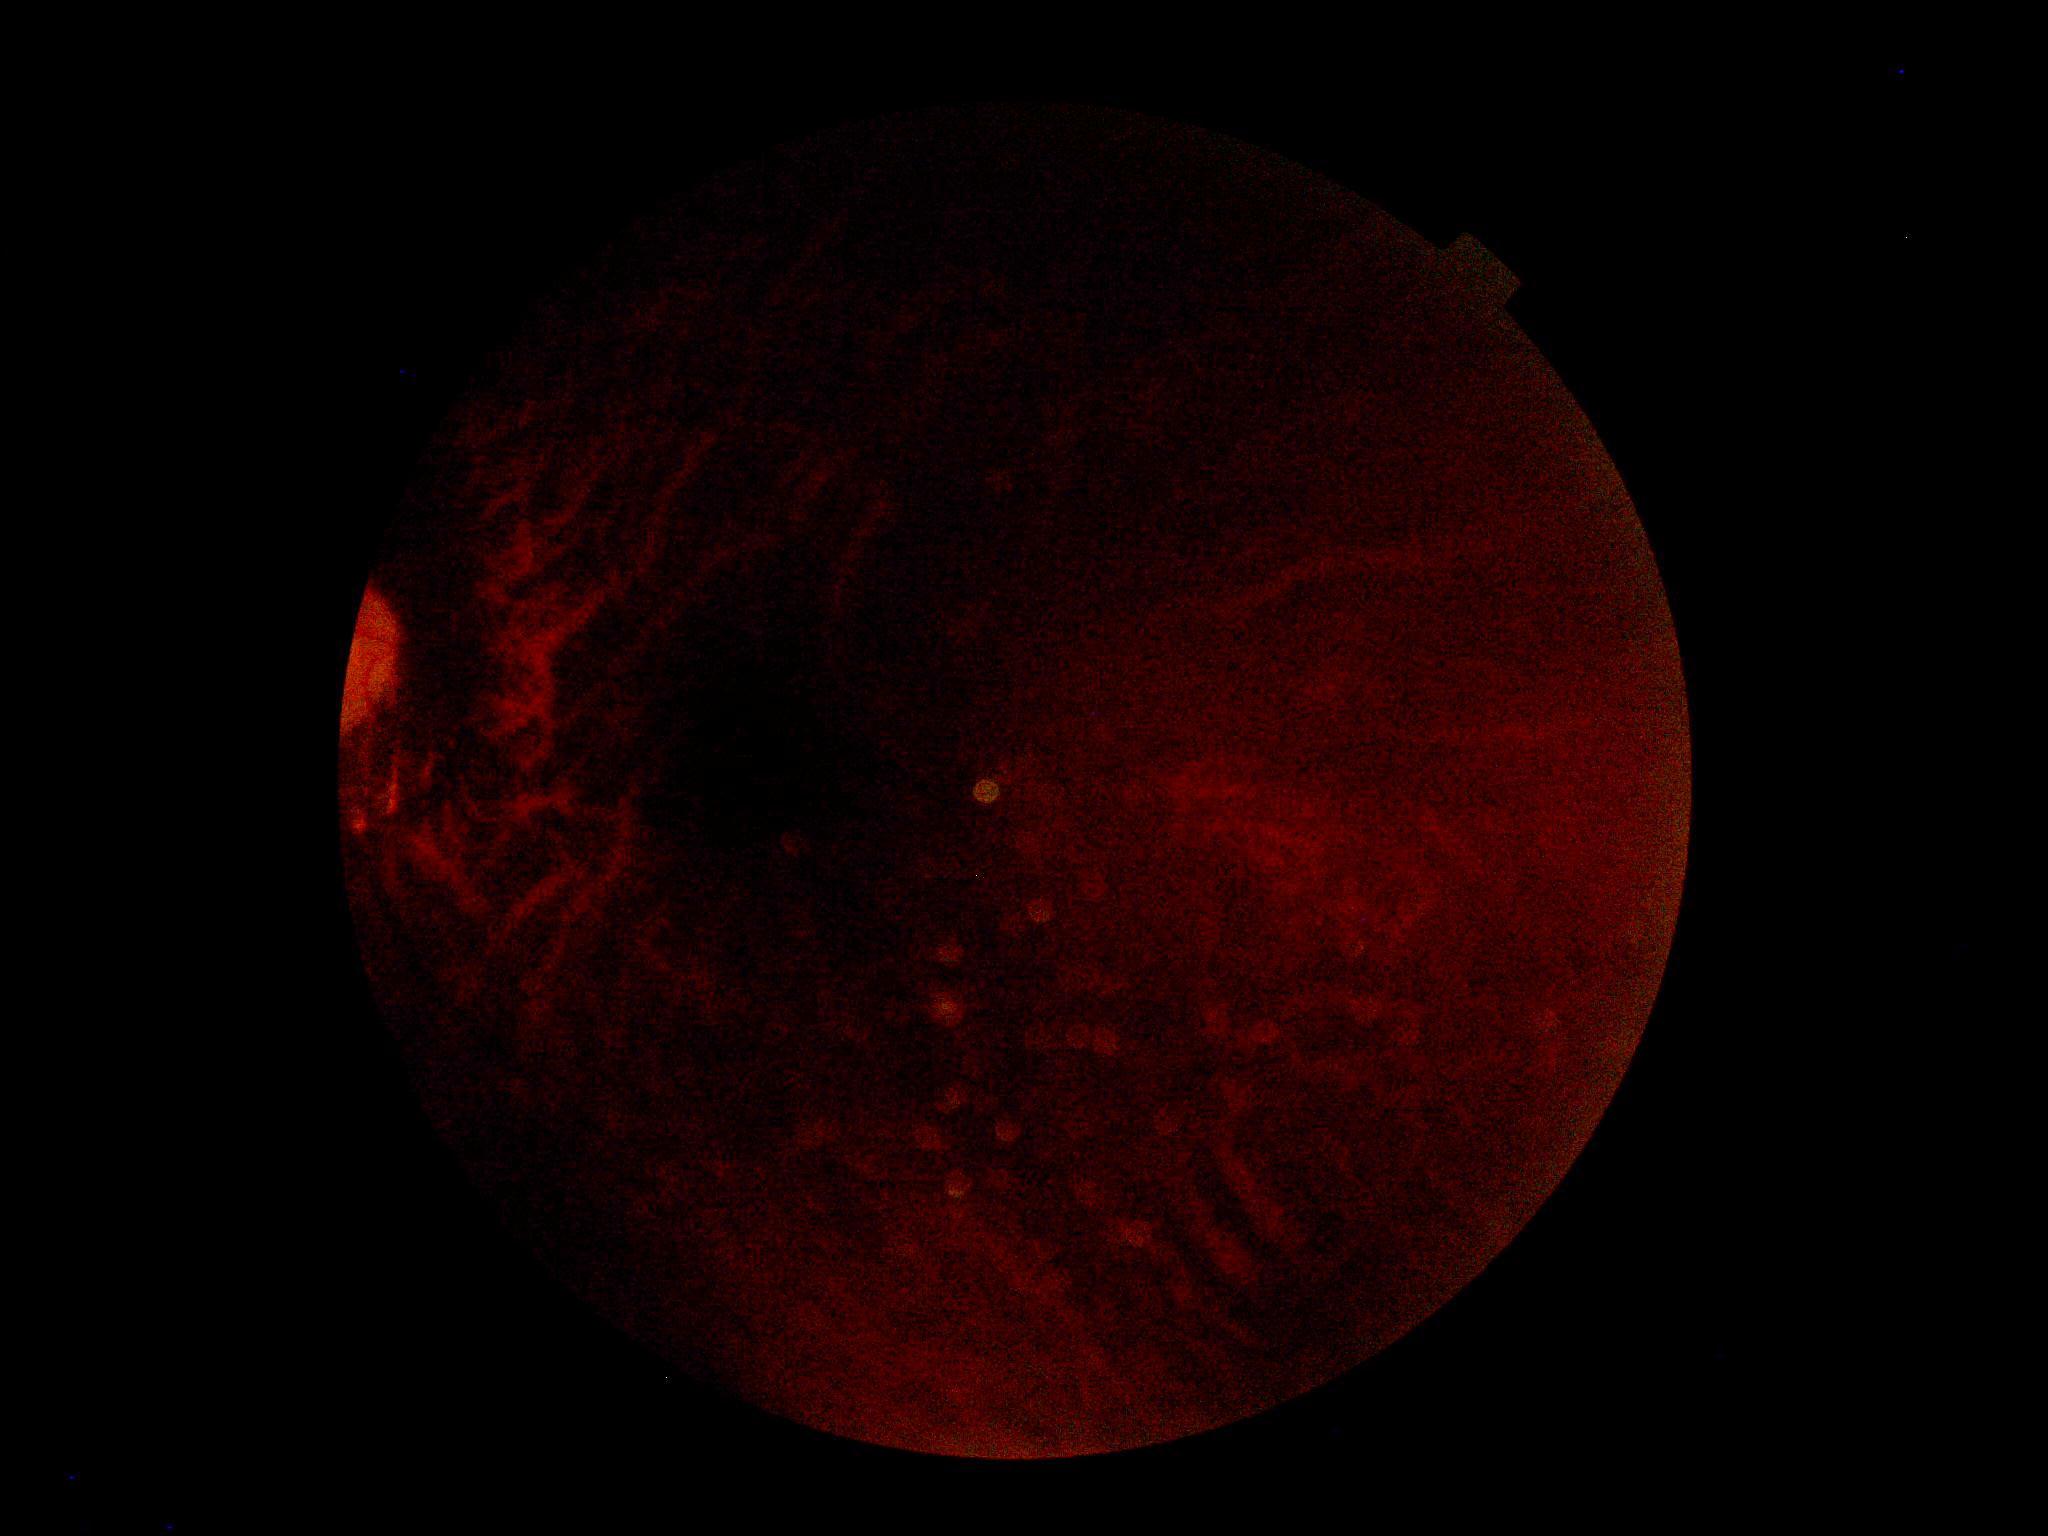

image quality = insufficient | DR stage = ungradable.